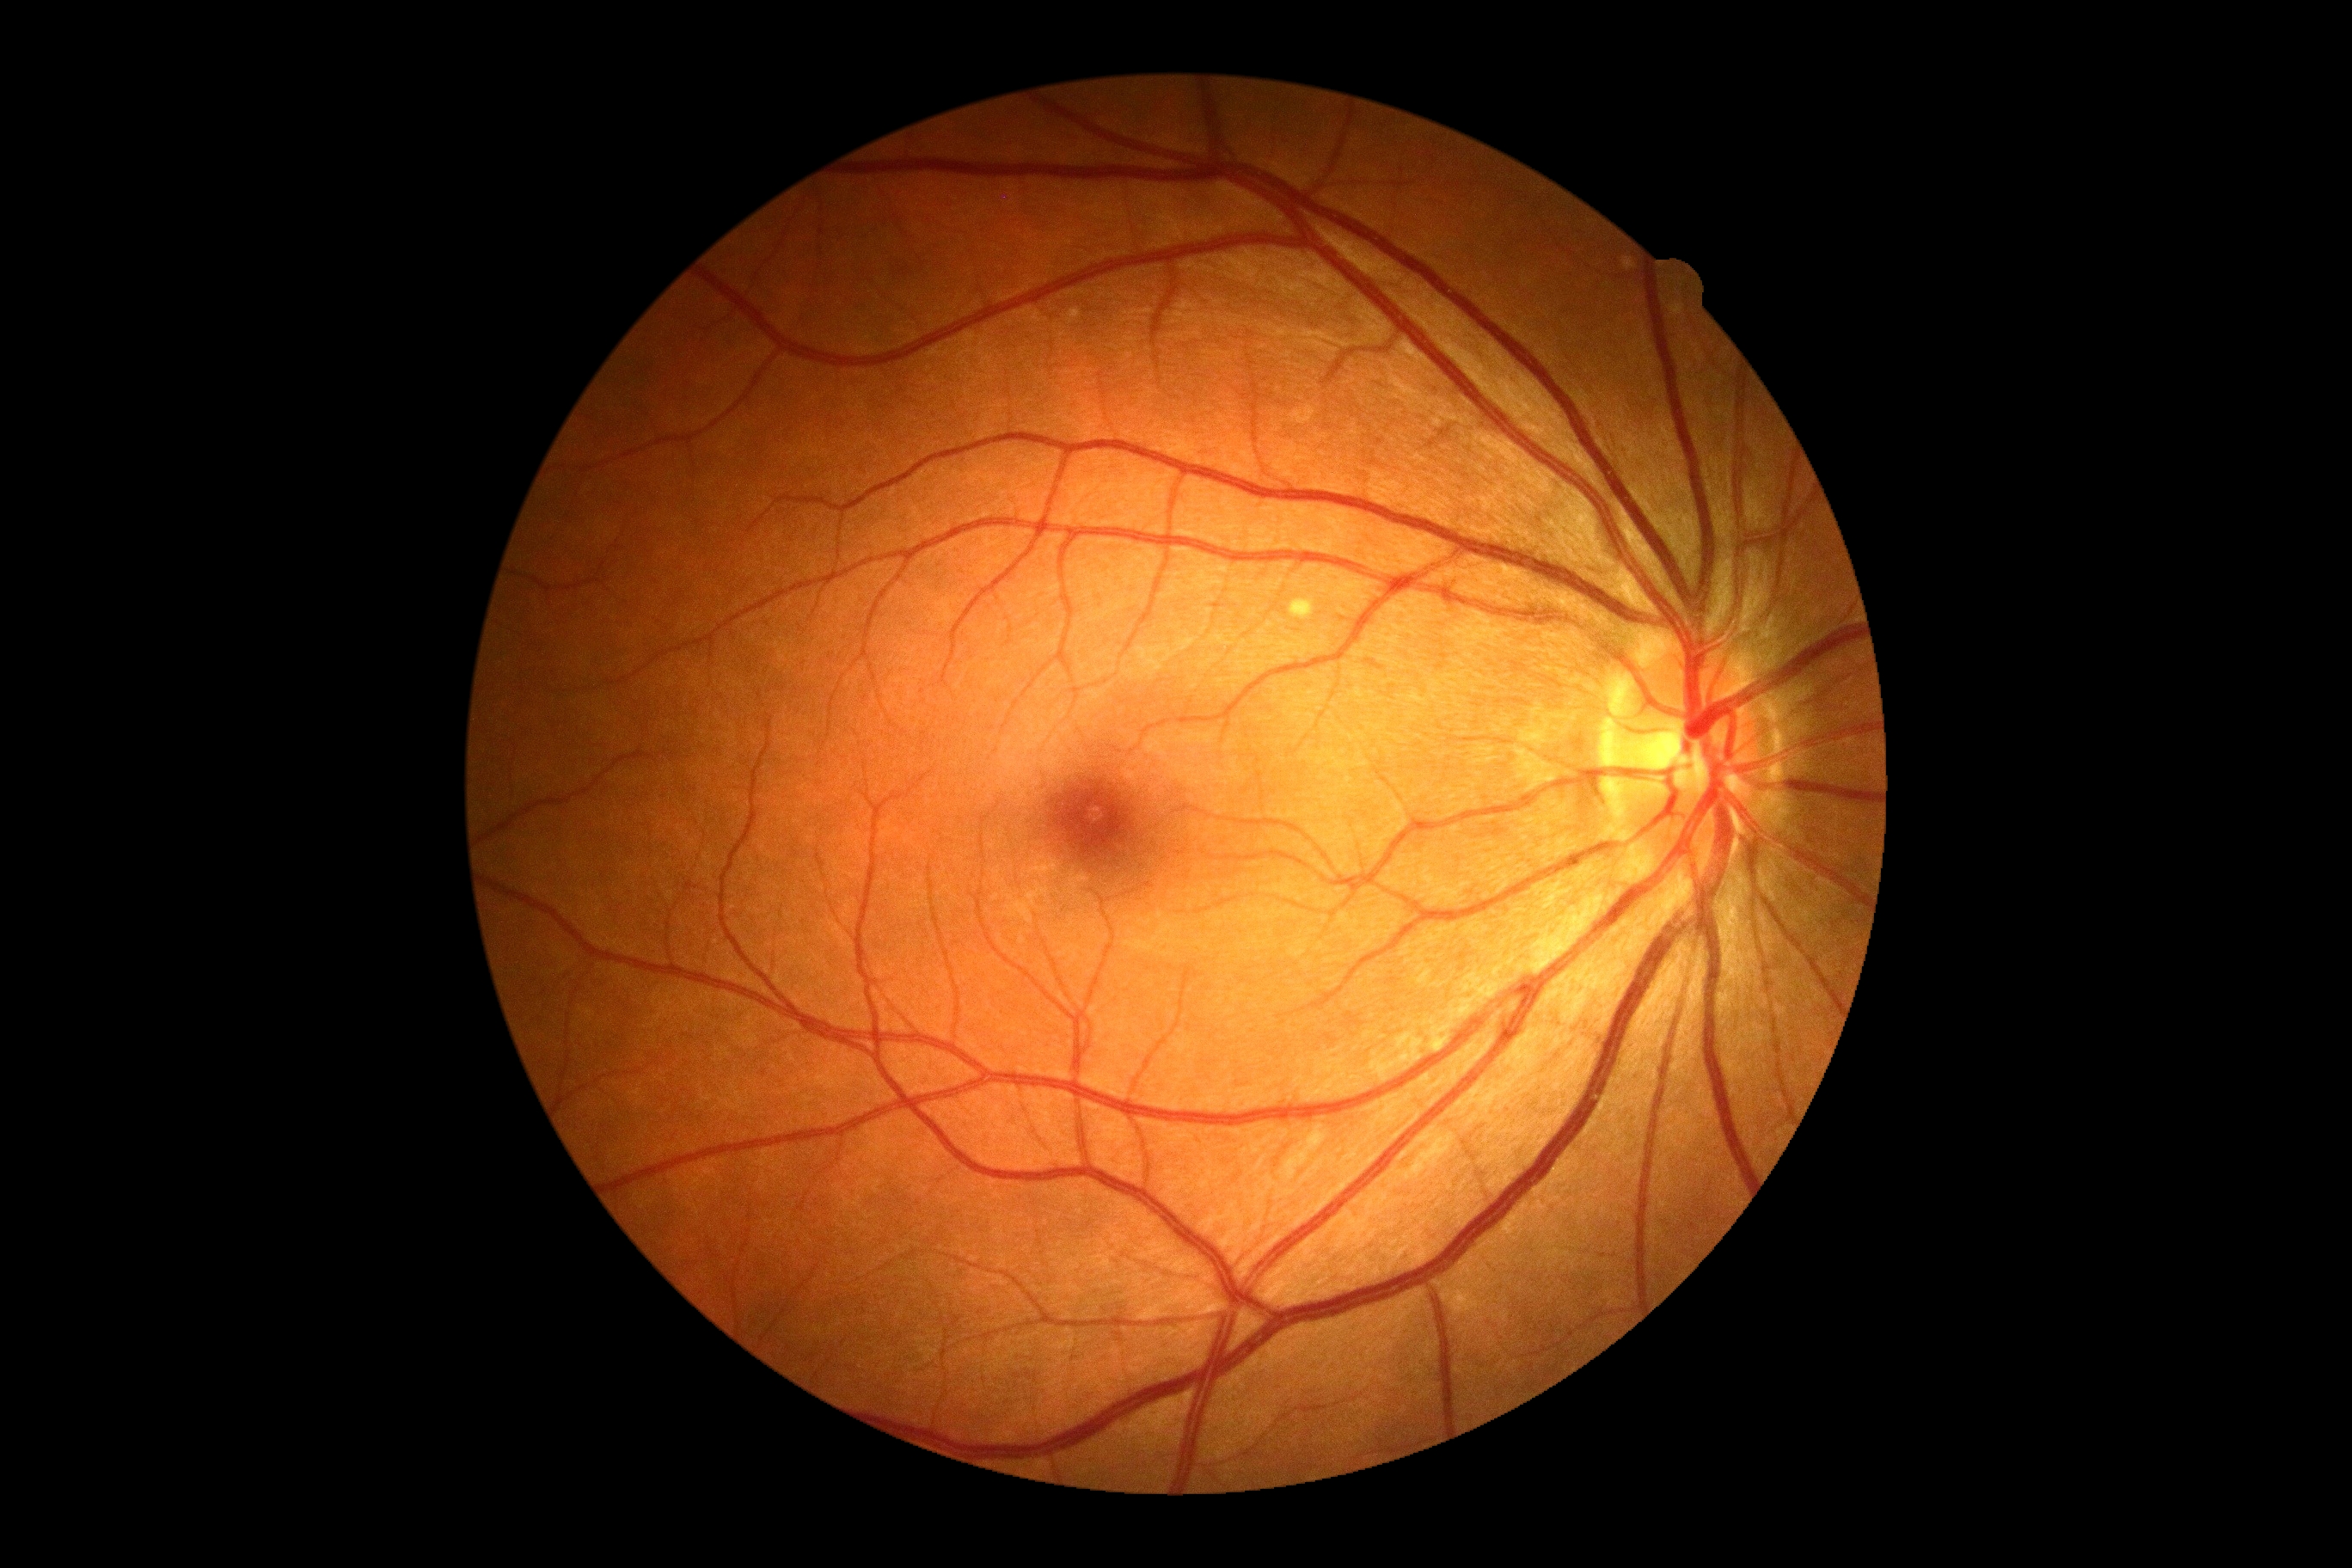 DR grade@no apparent retinopathy (0); DR impression@no signs of DR.